640x480px. Infant wide-field fundus photograph: 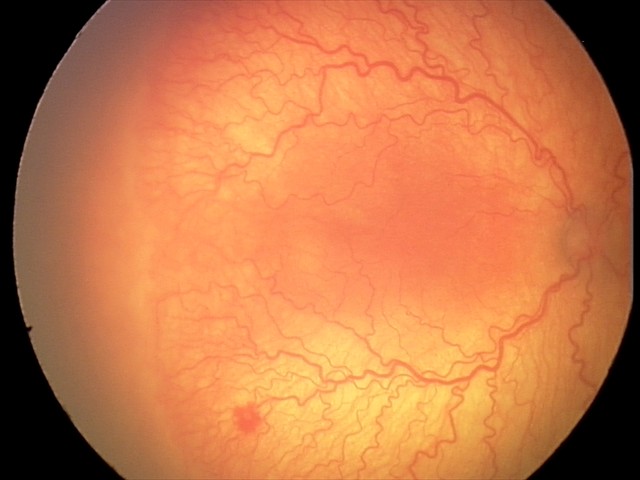
Plus disease present.
Diagnosis from this screening exam: aggressive retinopathy of prematurity.